2048x1536px
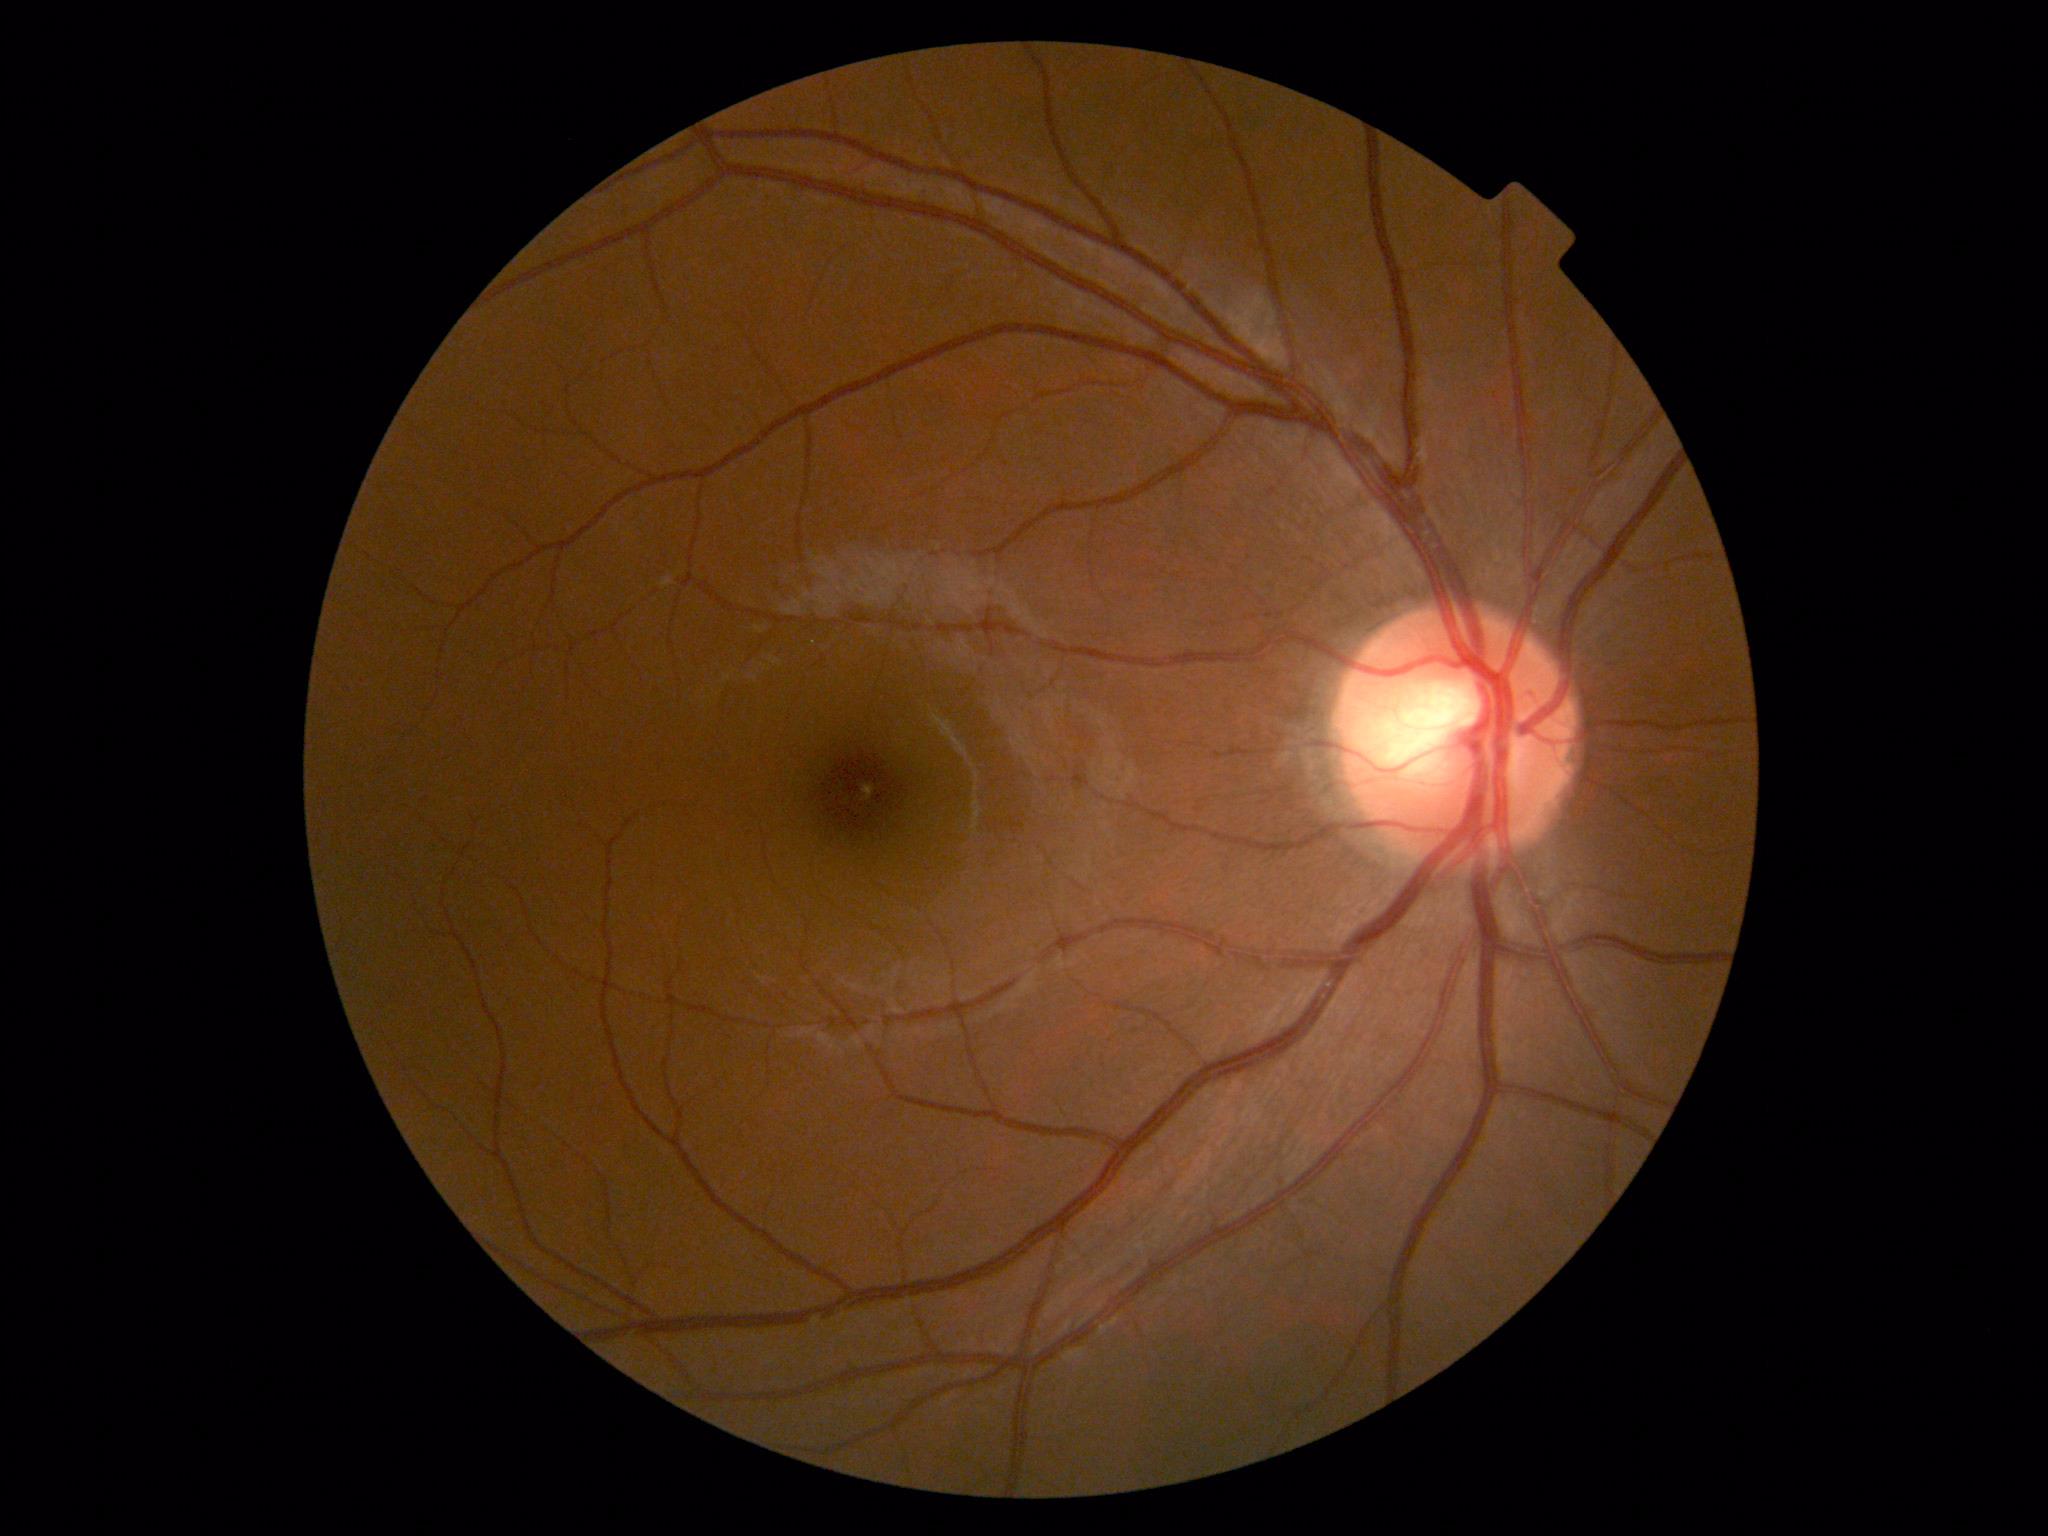 retinopathy = no apparent retinopathy (grade 0).